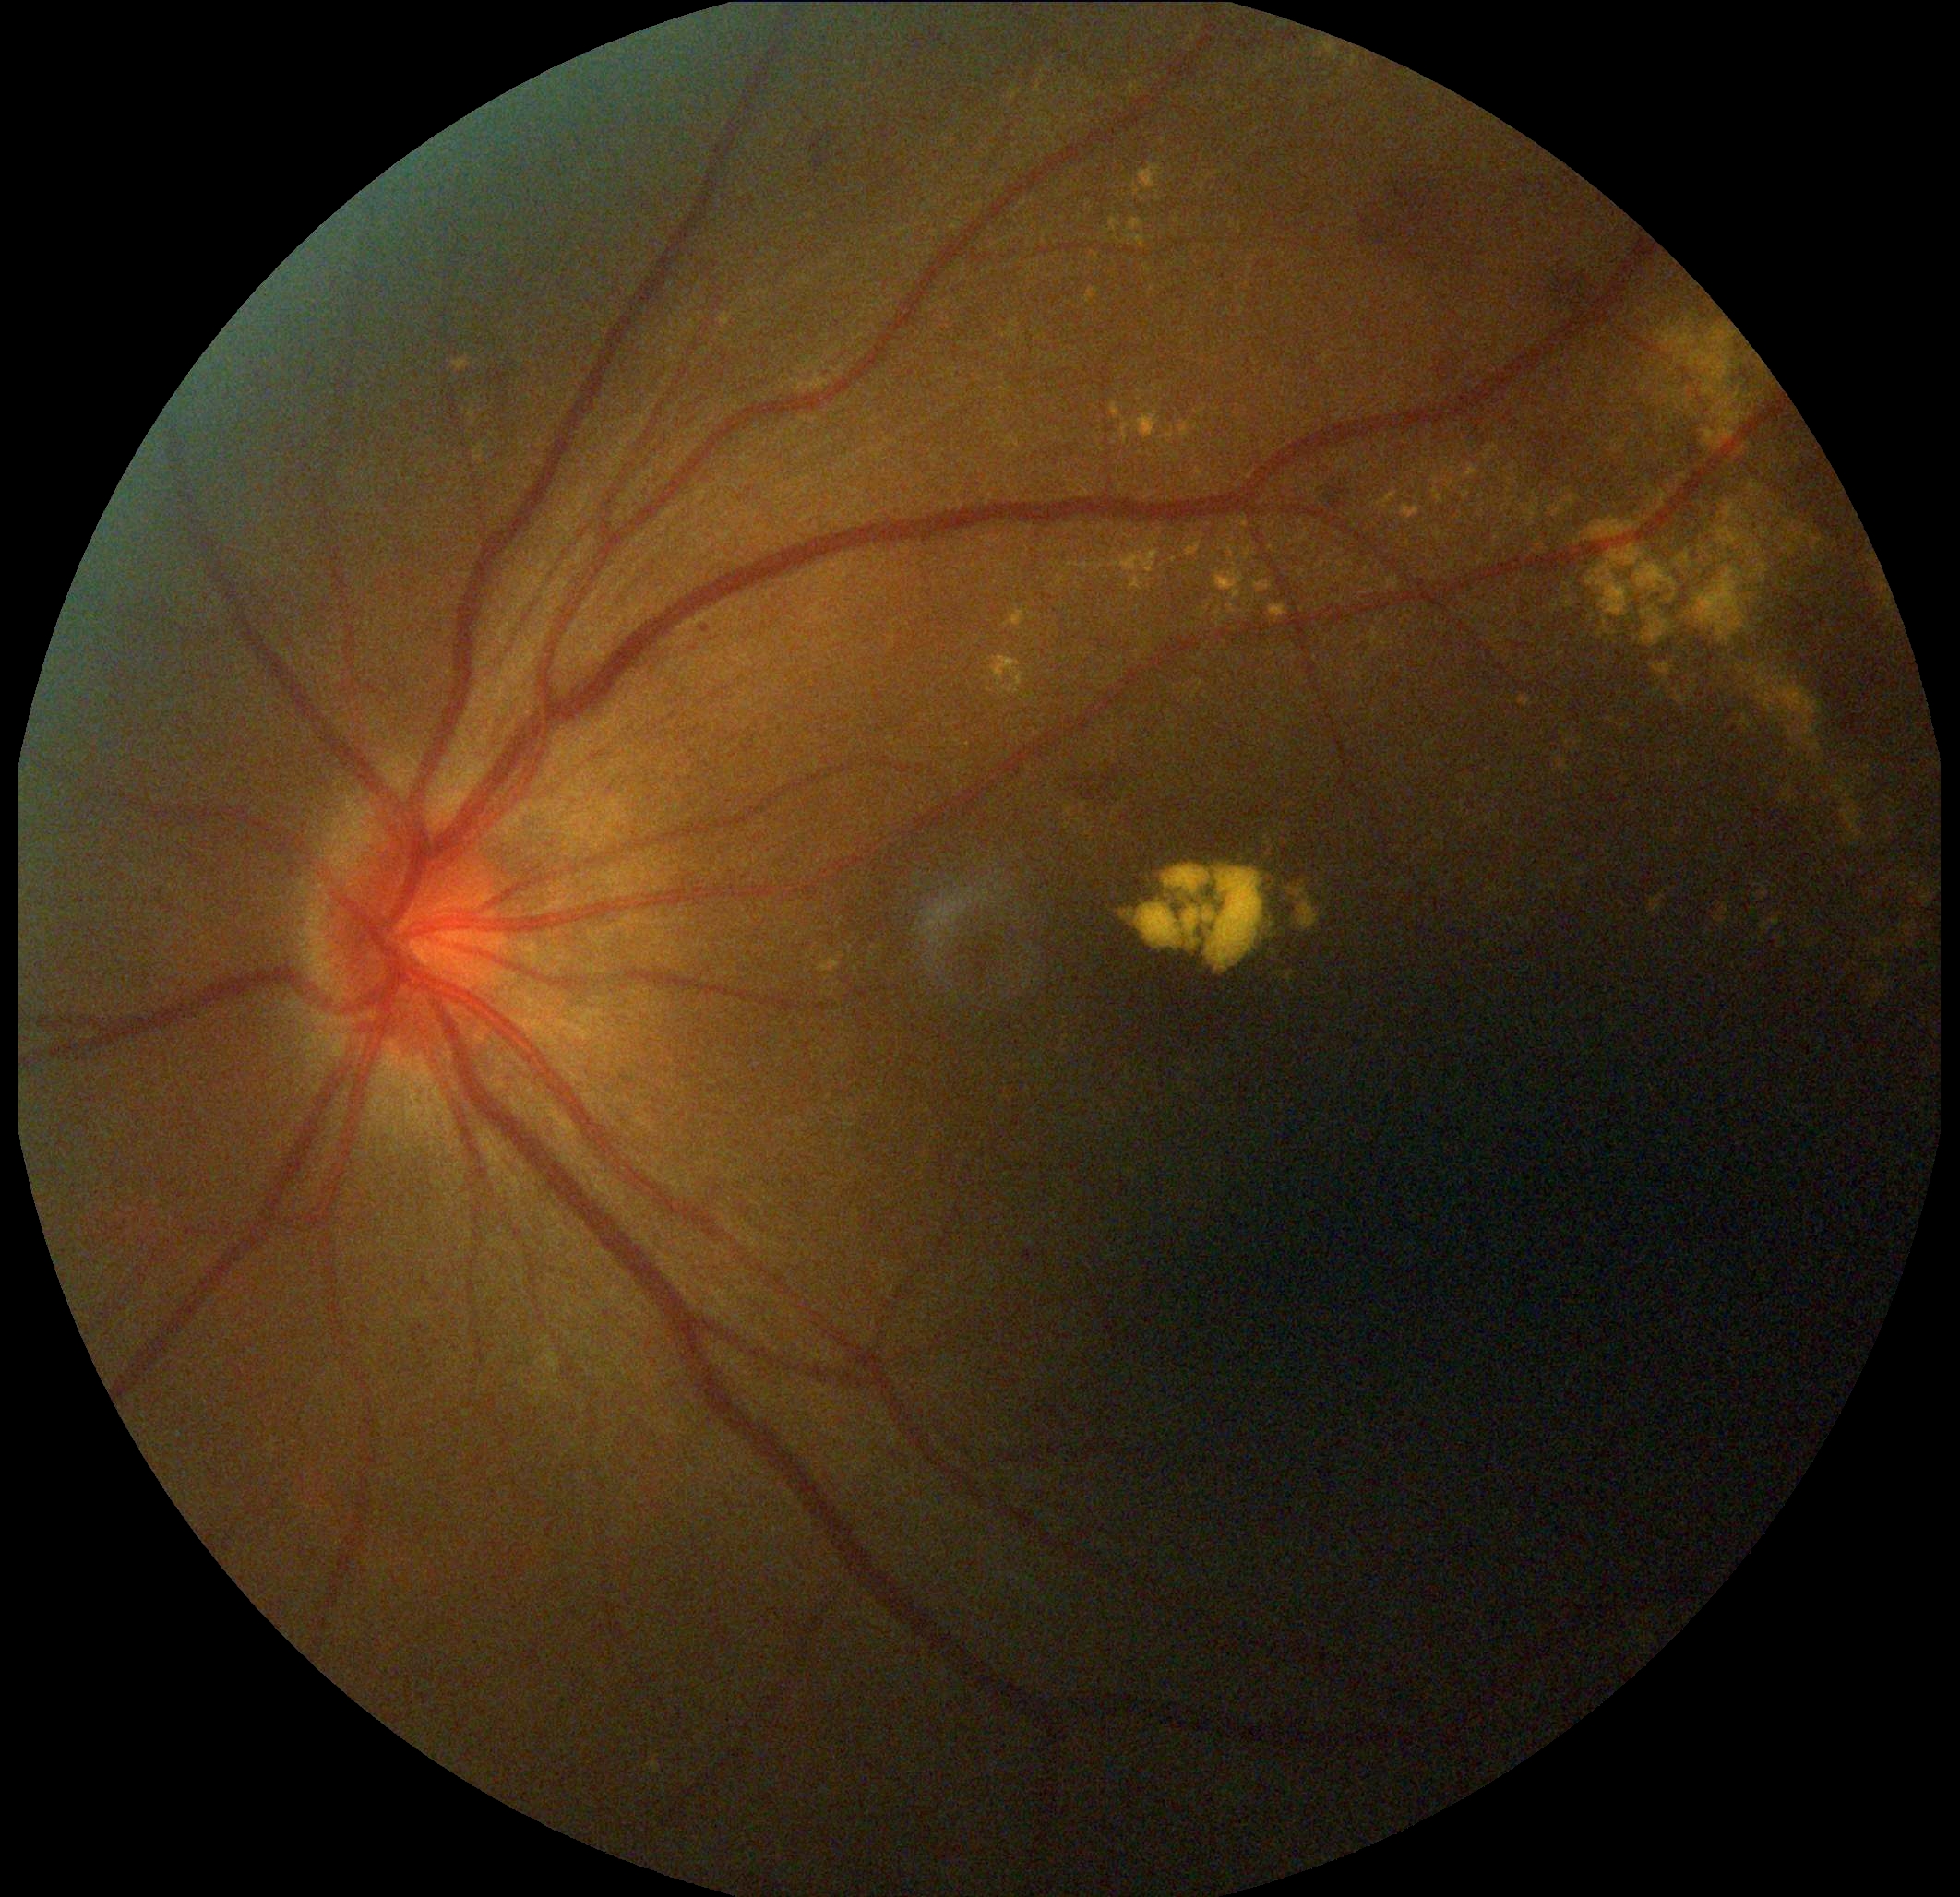
DR grade is 2 — more than just microaneurysms but less than severe NPDR.